Nonmydriatic fundus photograph.
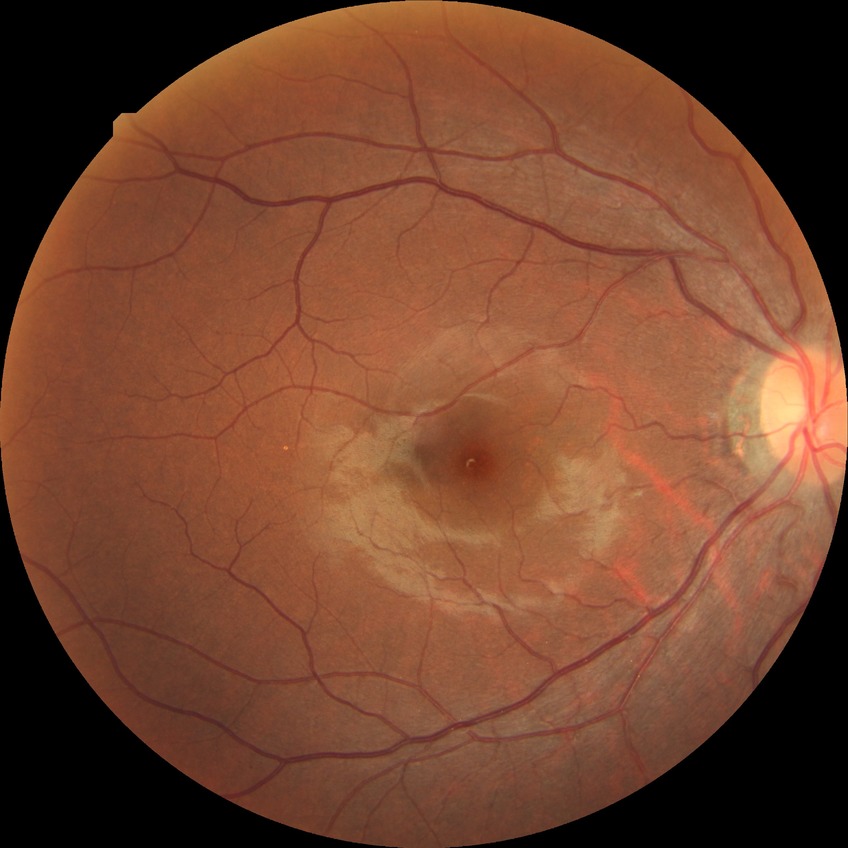

davis_grade: NDR